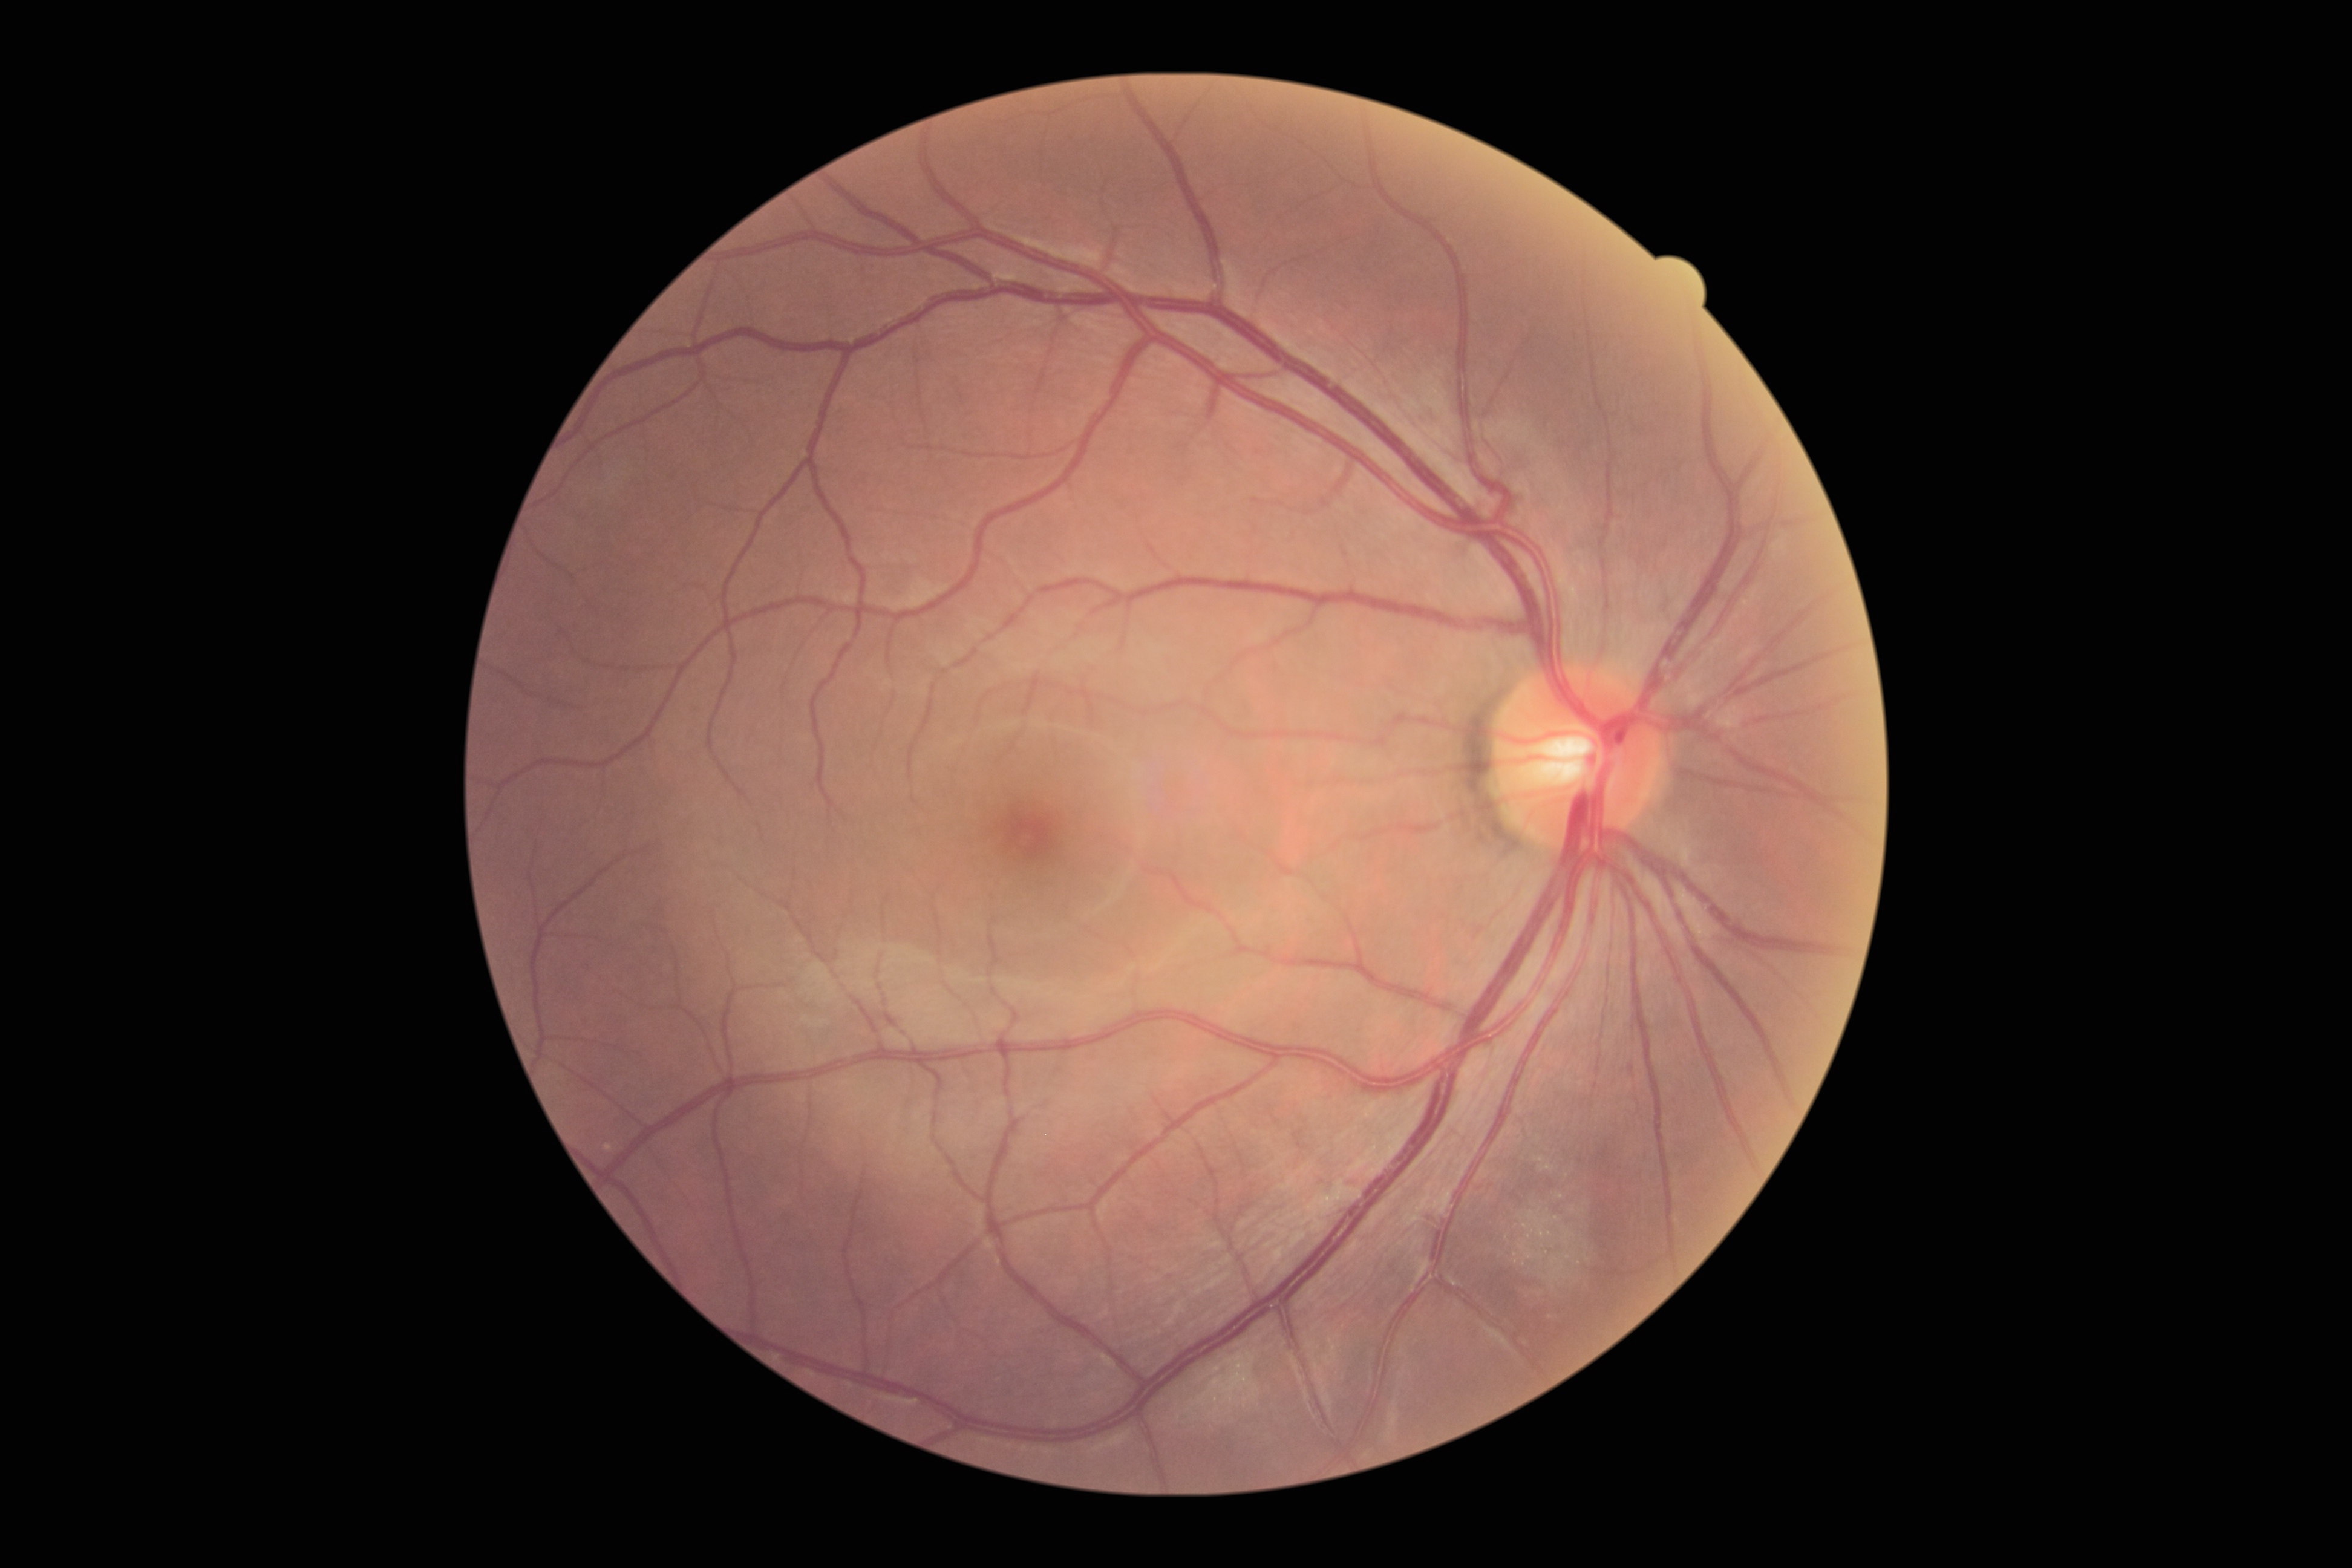 DR severity: grade 0 — no visible signs of diabetic retinopathy | DR impression: no apparent DR.